Color fundus image · 512x512px: 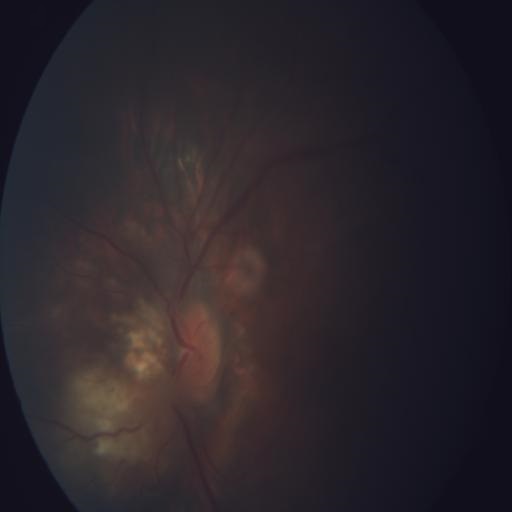 Showing tilted disc (TD).